2048x1536 — 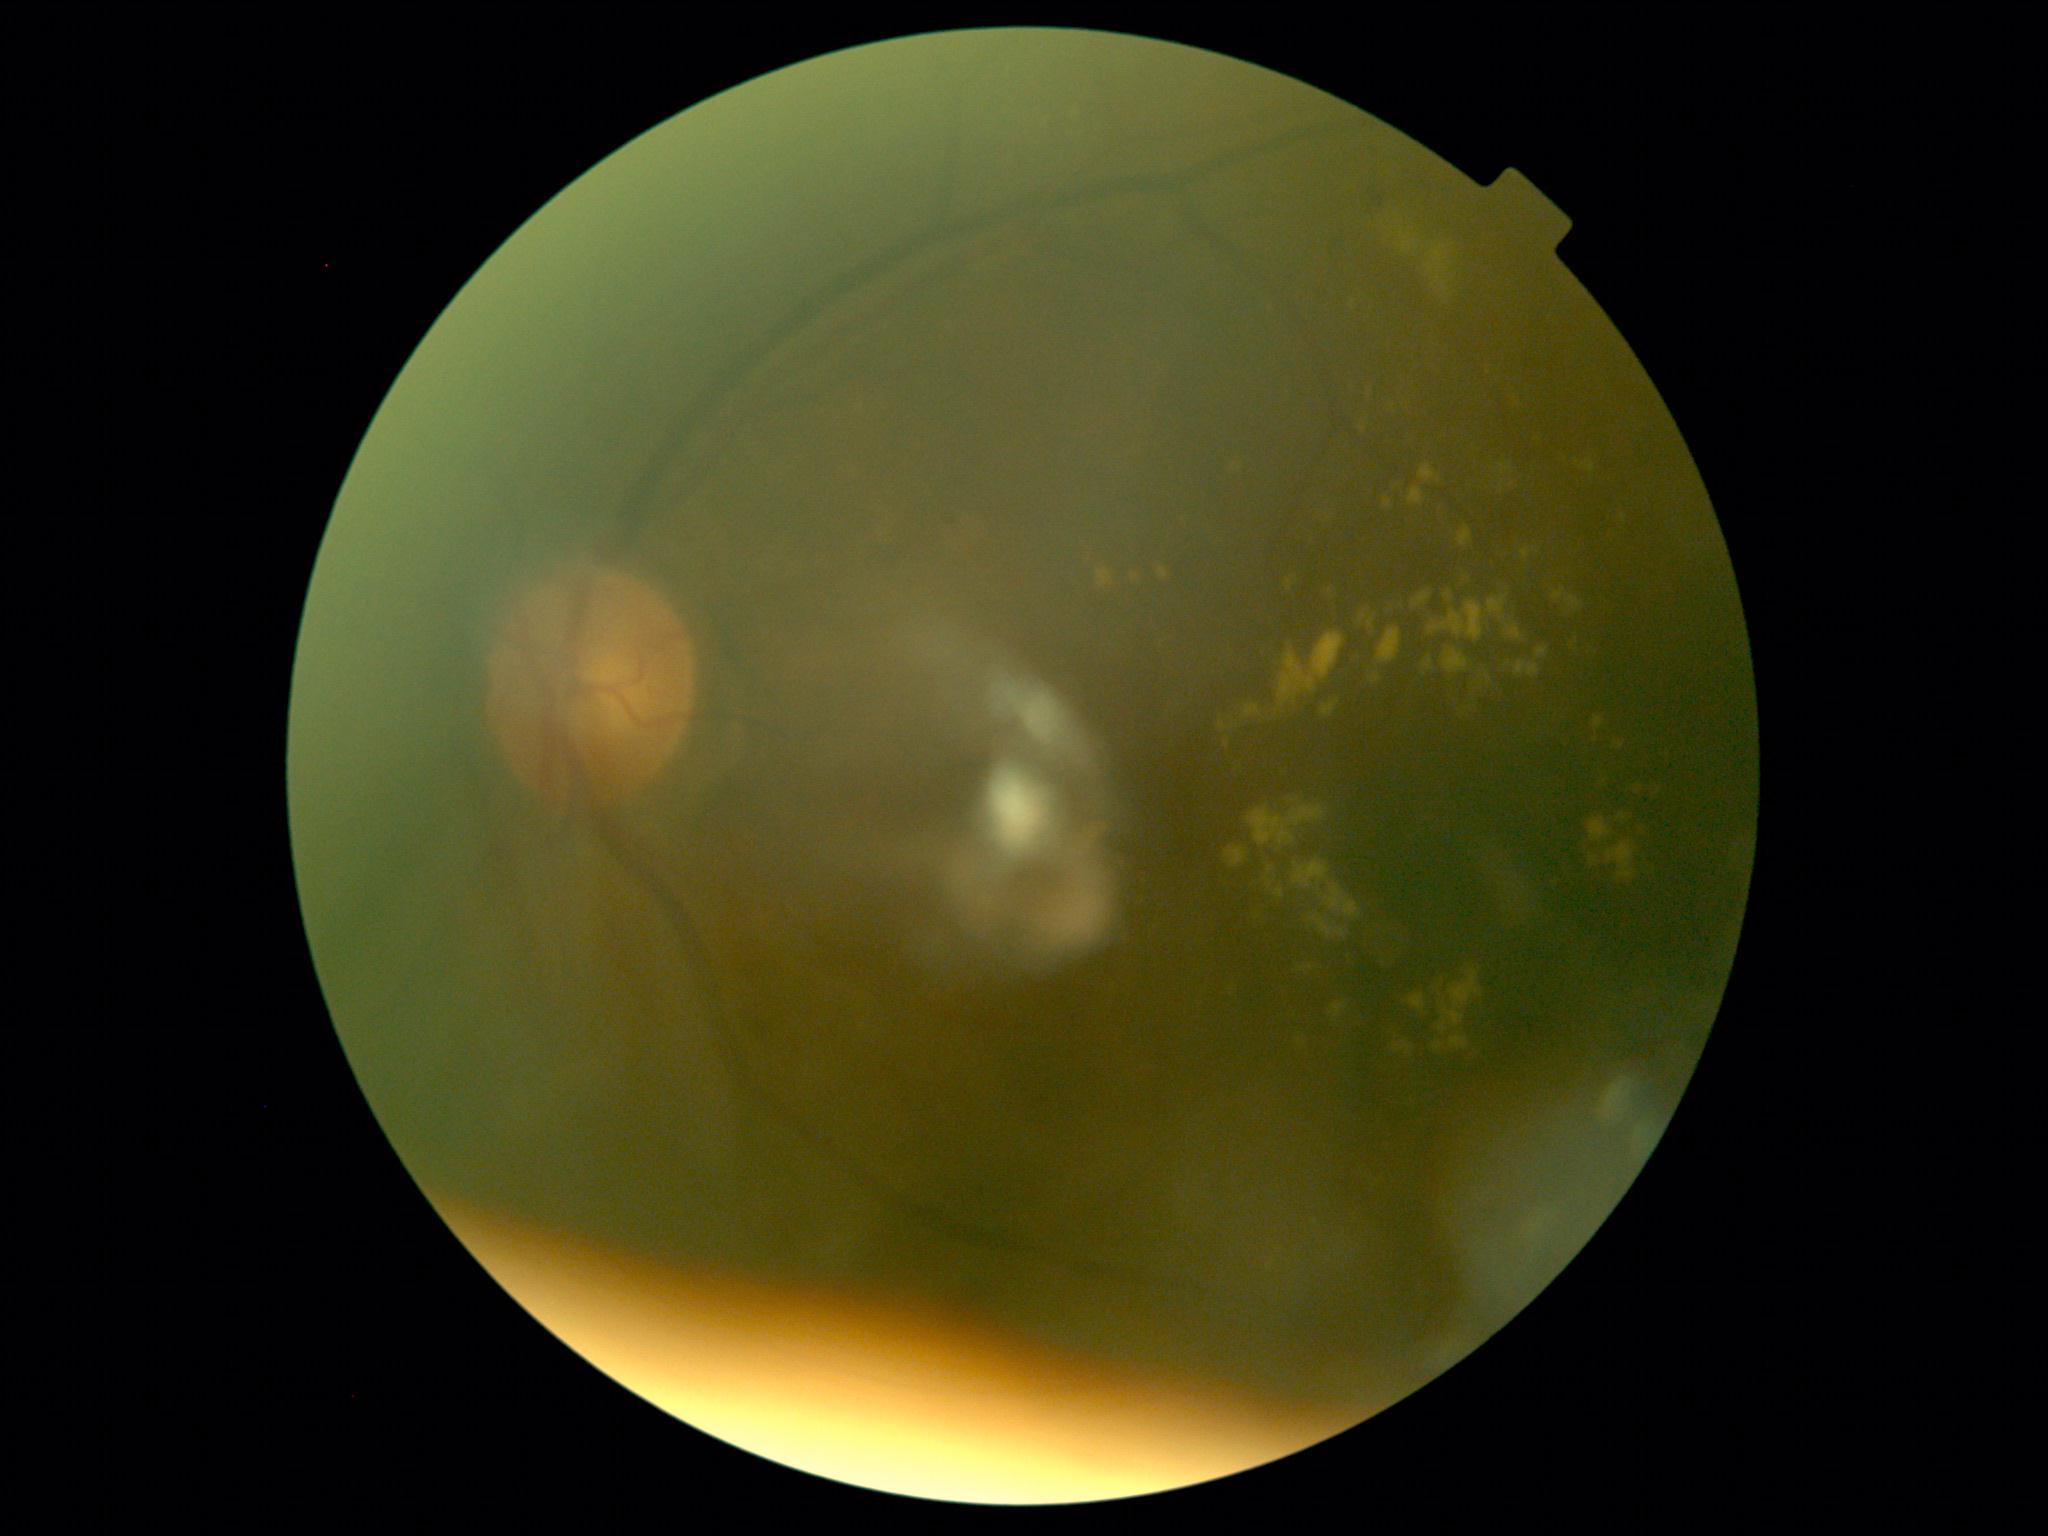 Diabetic retinopathy (DR) is grade 2 (moderate NPDR).